NIDEK AFC-230. Color fundus photograph: 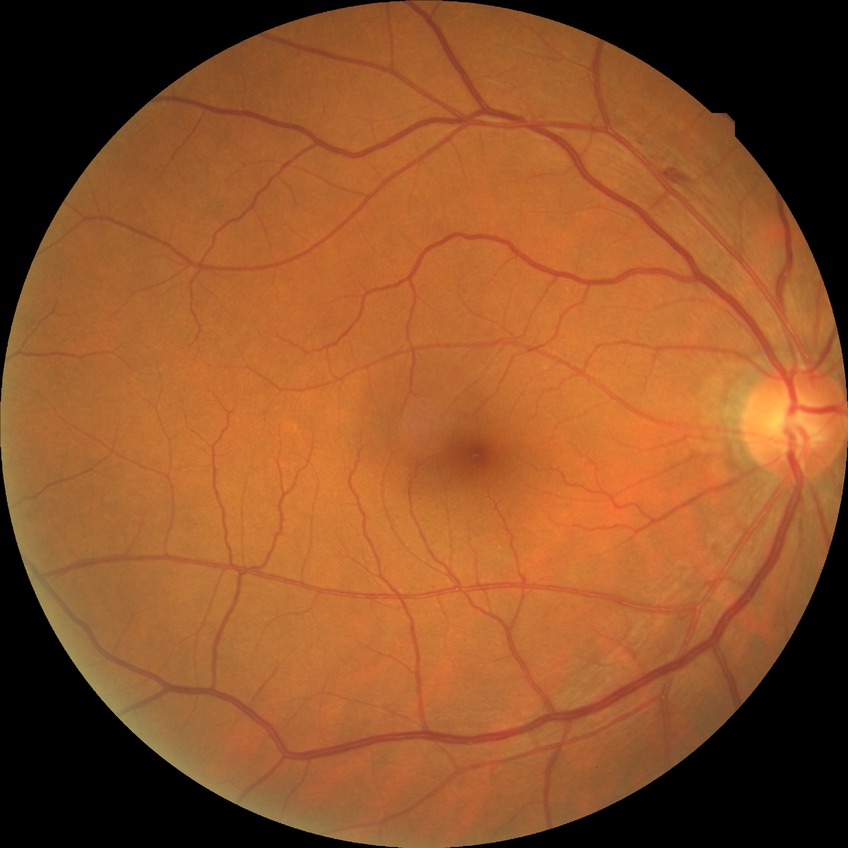 Davis DR grade@PPDR.